728x723px; color fundus image; FOV: 45 degrees — 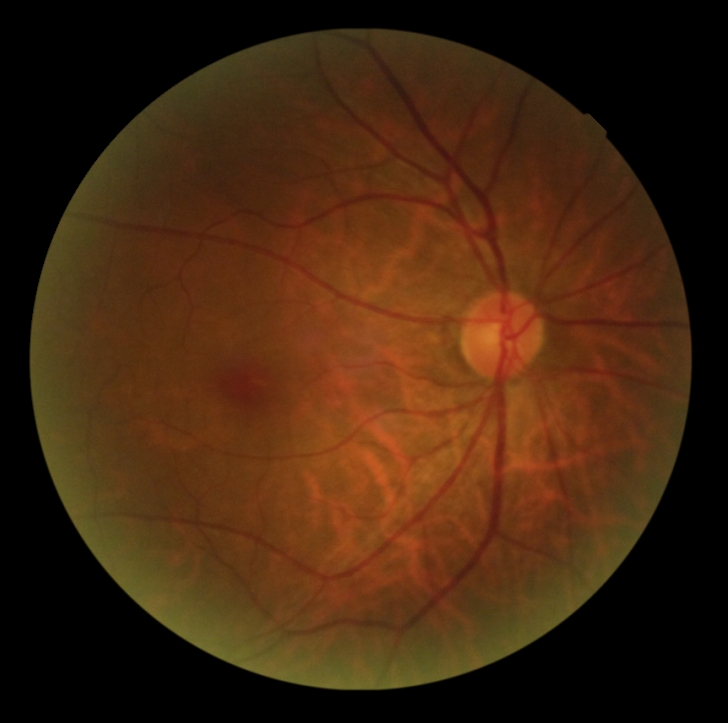

Diabetic retinopathy (DR) is grade 0 (no apparent retinopathy). No signs of diabetic retinopathy.